DR severity per modified Davis staging. No pharmacologic dilation.
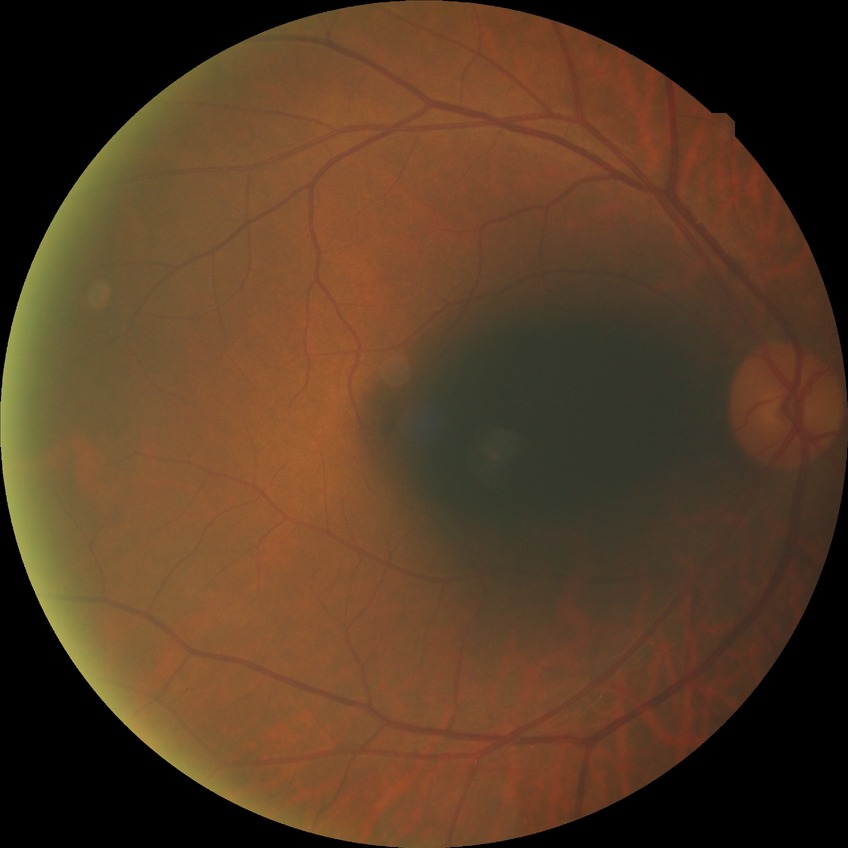

Diabetic retinopathy (DR): no diabetic retinopathy (NDR).